Camera: NIDEK AFC-230. Graded on the modified Davis scale: 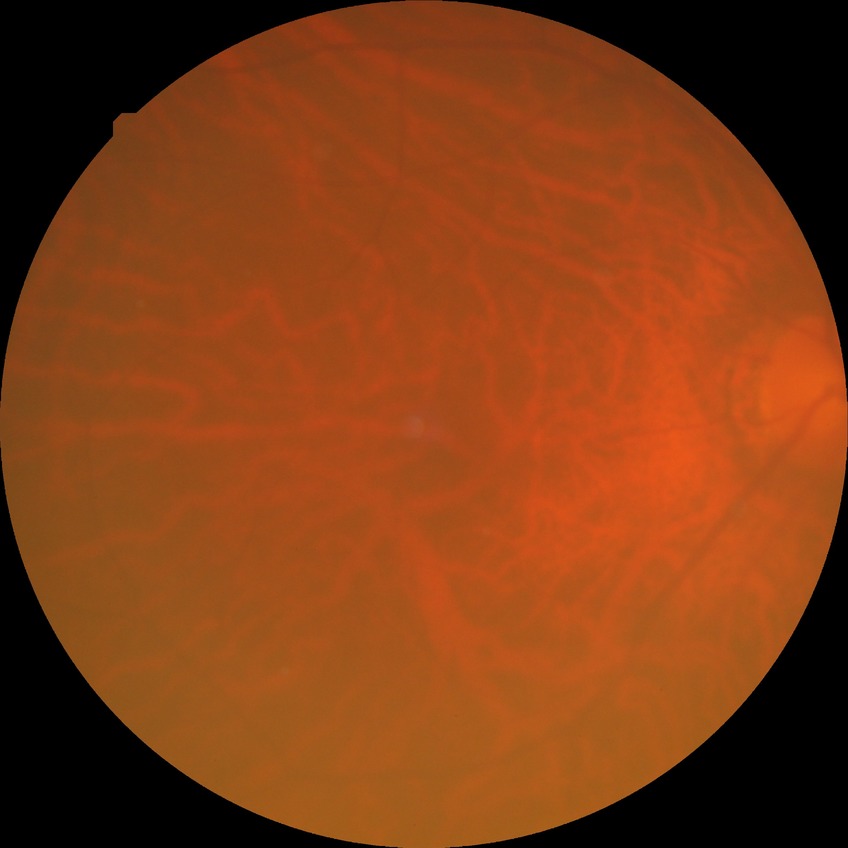 DR impression = no DR findings | modified Davis grade = NDR.